45° FOV
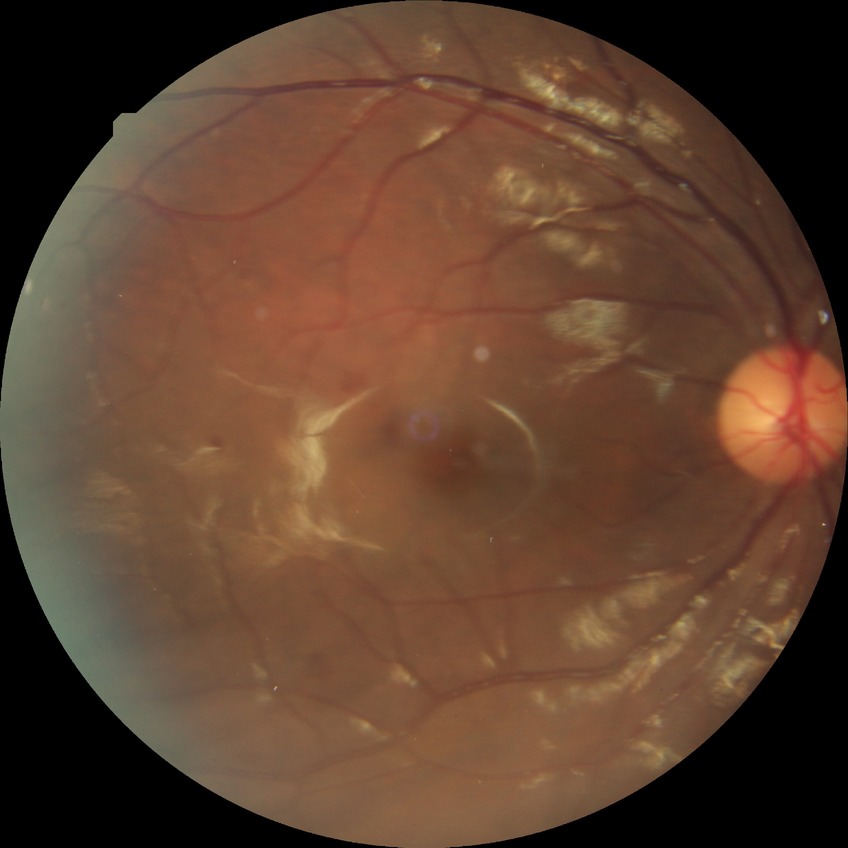
Davis grading@no diabetic retinopathy.